45° FOV. Color fundus image:
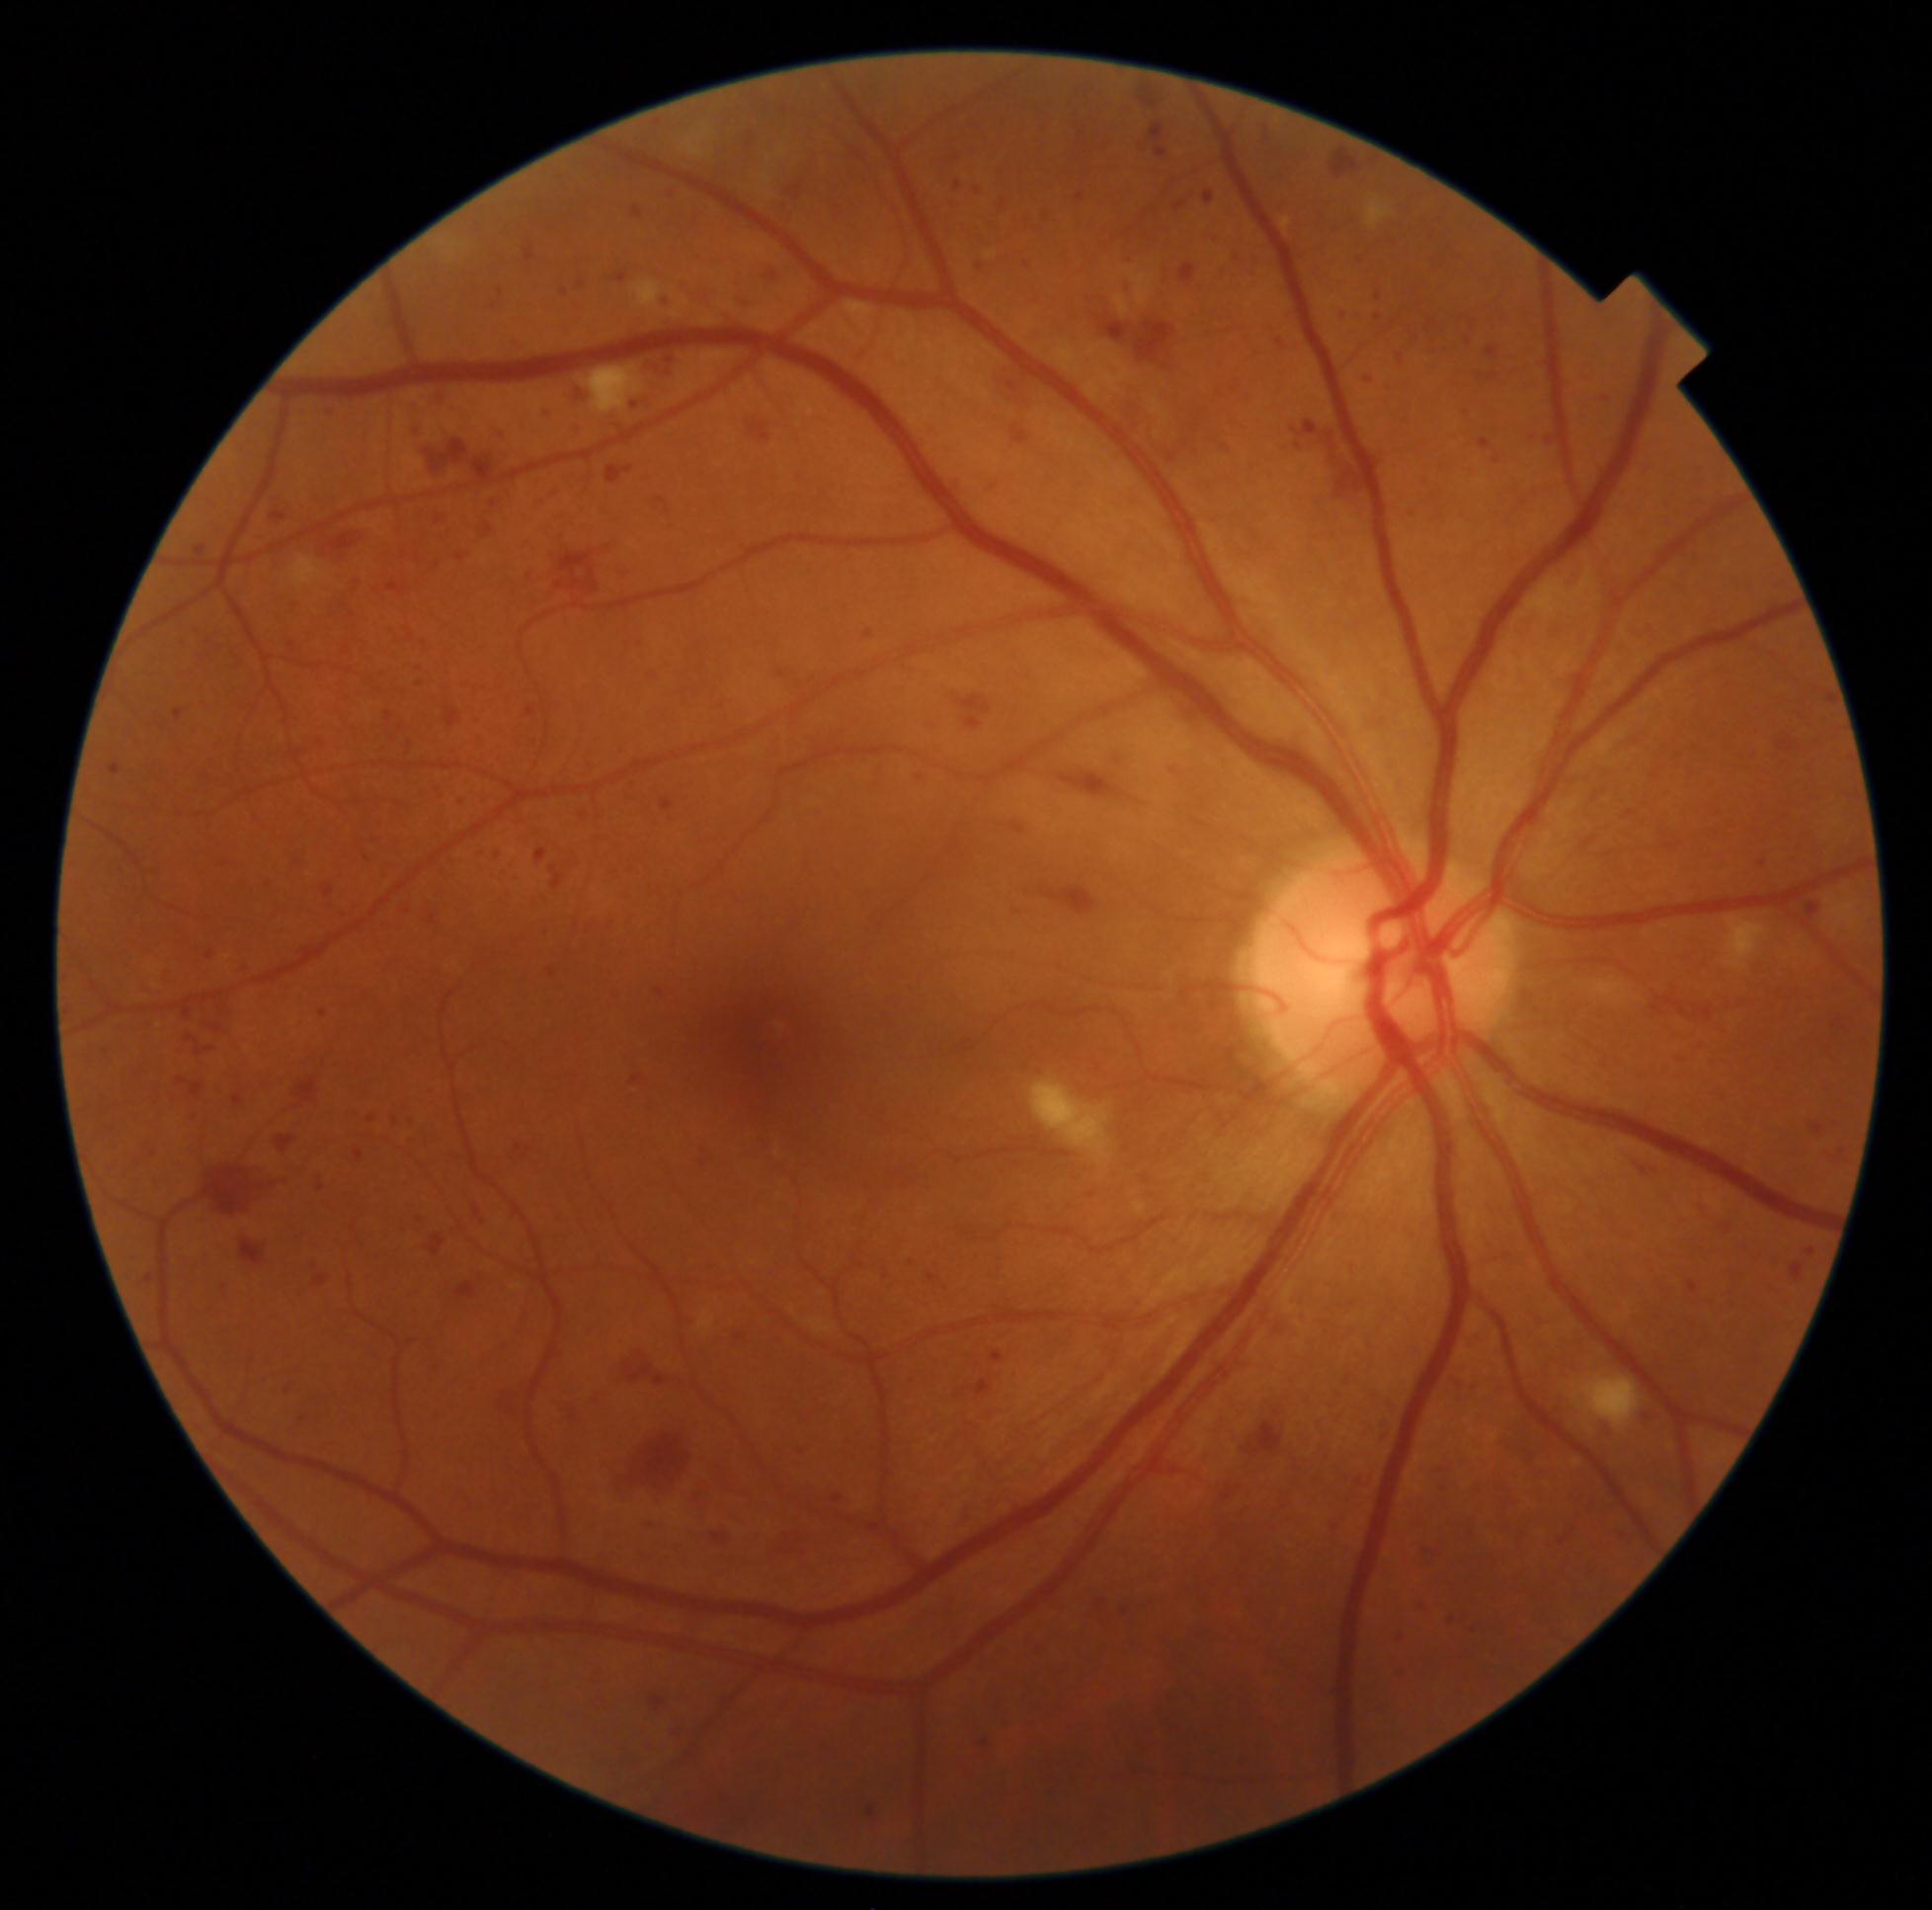 {"partial": true, "dr_grade": 3, "dr_grade_name": "severe NPDR", "lesions": {"he": [[274, 1133, 303, 1159], [1802, 1246, 1819, 1263], [1218, 269, 1231, 281], [1105, 749, 1129, 772], [1773, 720, 1845, 758], [1523, 1310, 1550, 1327], [647, 669, 663, 683], [1492, 456, 1501, 465], [1594, 392, 1616, 407], [1779, 653, 1797, 669], [532, 499, 552, 510], [563, 613, 572, 629], [192, 726, 201, 739], [679, 283, 718, 314], [1678, 1217, 1695, 1228], [1375, 315, 1382, 323], [1498, 1434, 1521, 1452], [566, 421, 584, 440]], "he_small": [[320, 743], [1017, 913]]}}